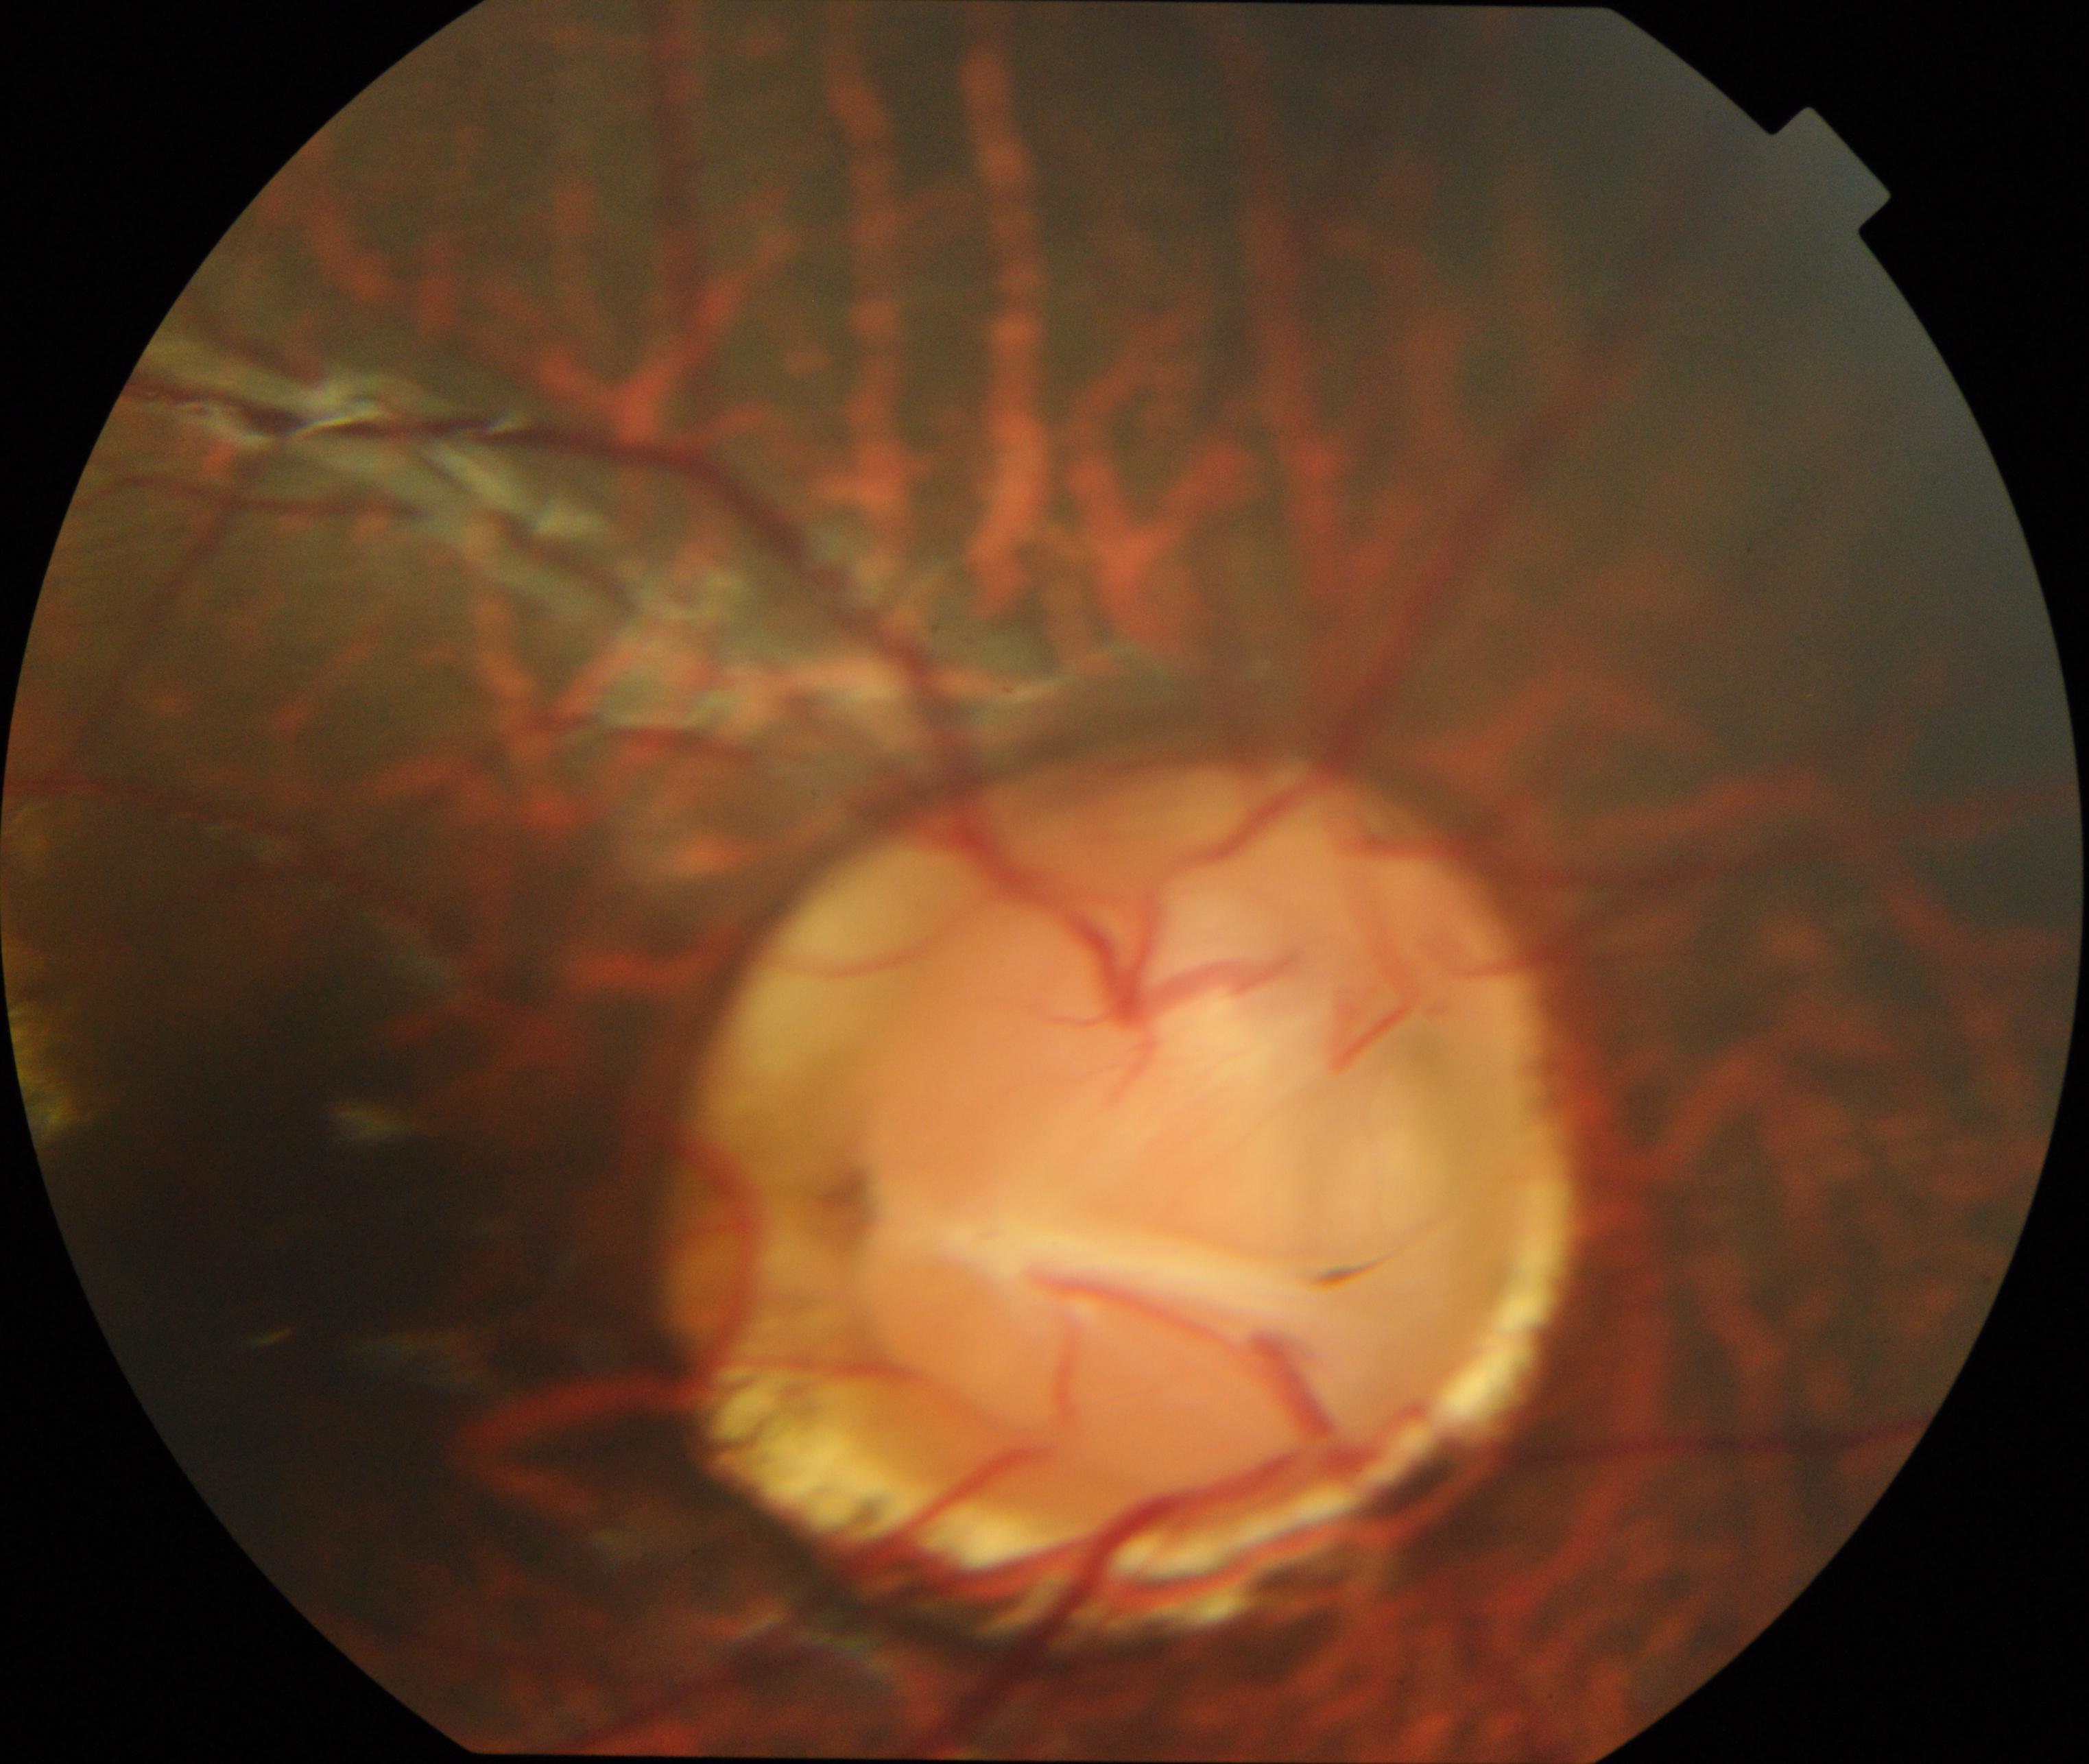 Color fundus photograph showing congenital disc abnormality.